Fundus photo: 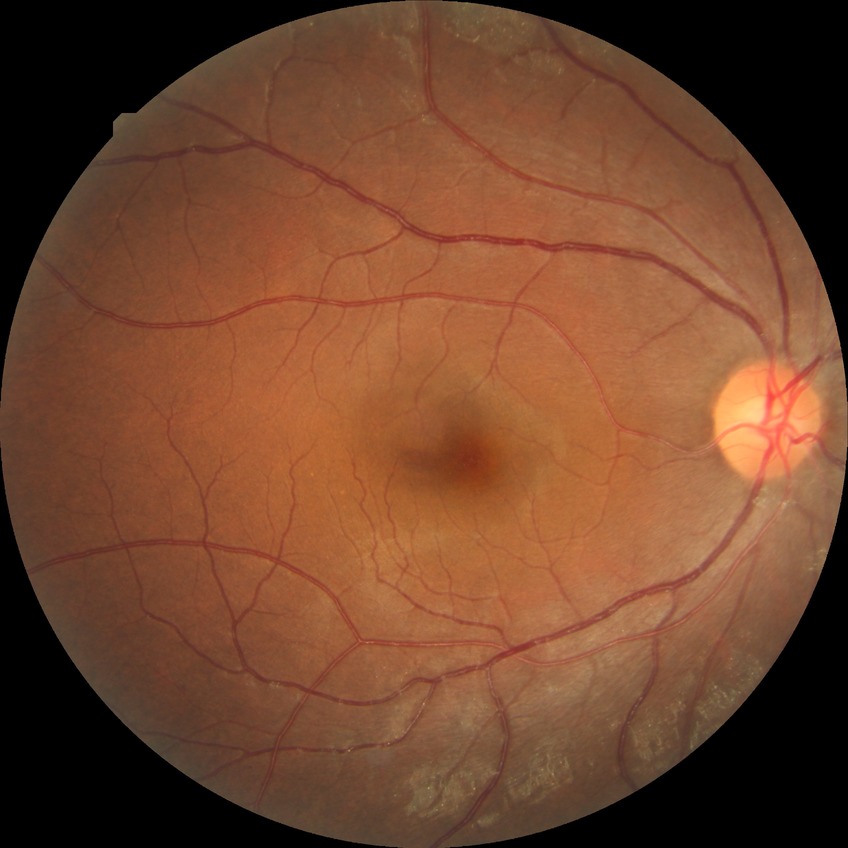

  davis_grade: no diabetic retinopathy